FOV: 45 degrees
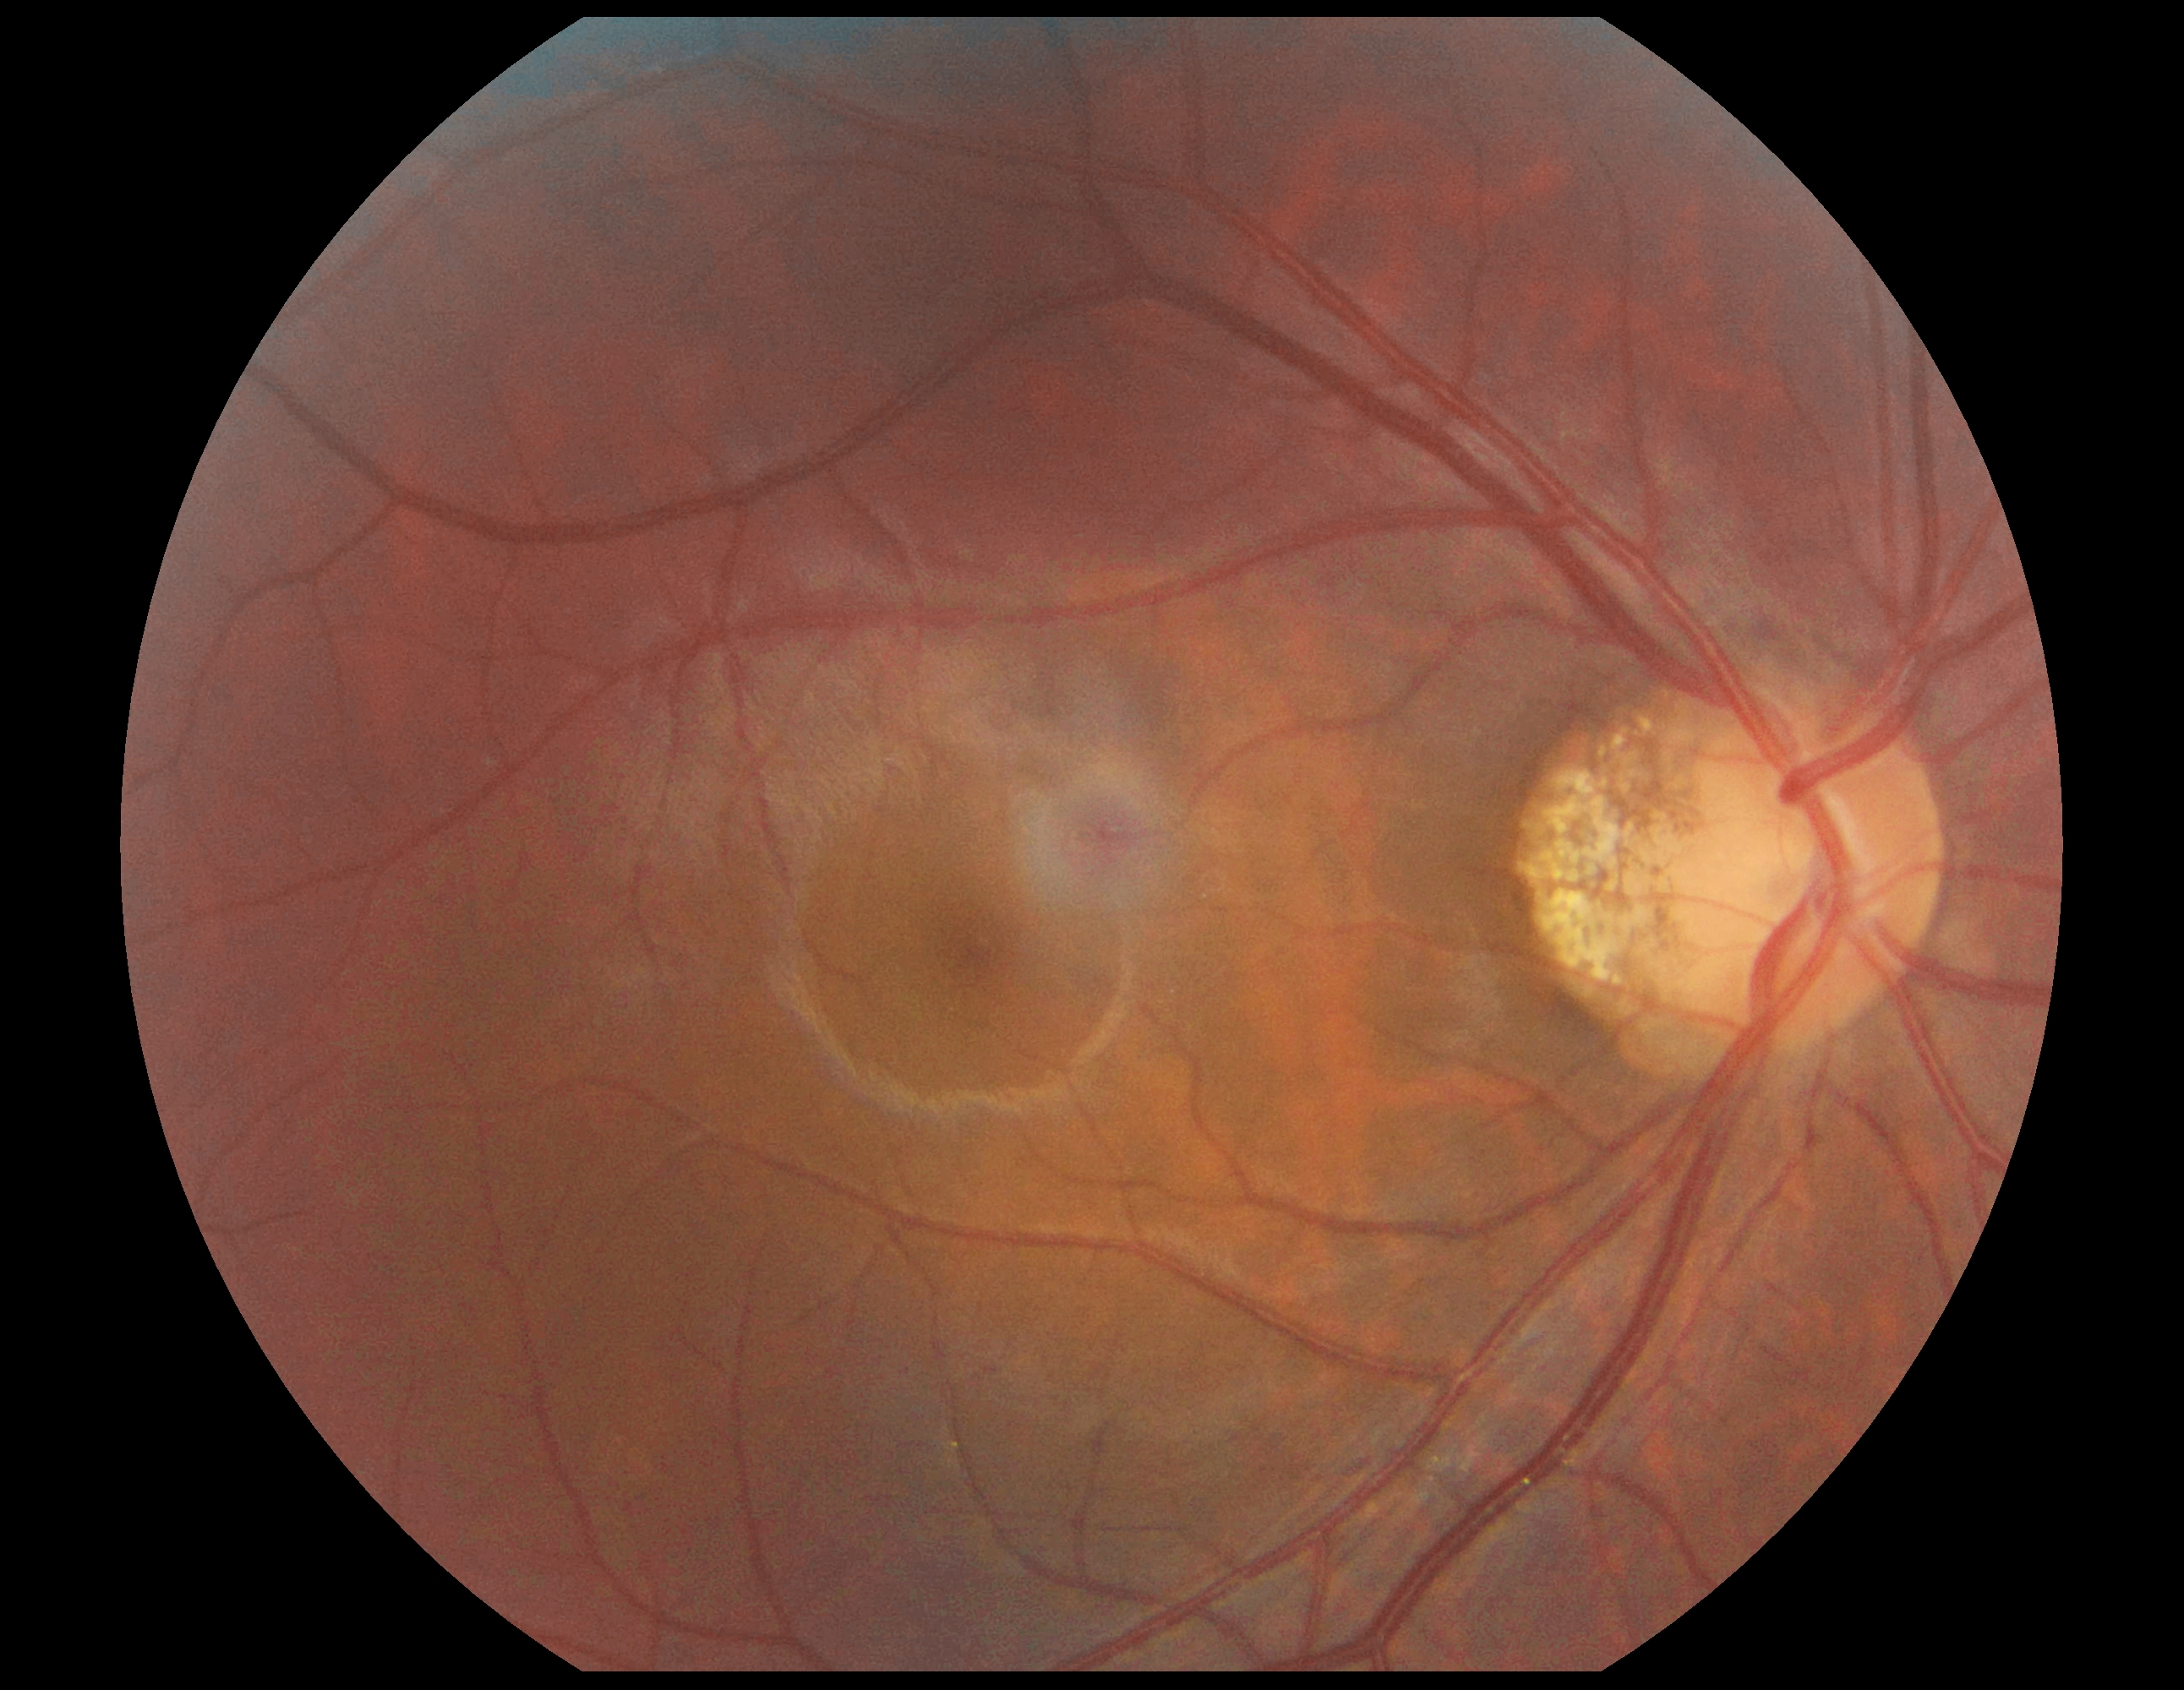

{"dr_grade": "0"}